130° field of view (Clarity RetCam 3); wide-field fundus photograph of an infant.
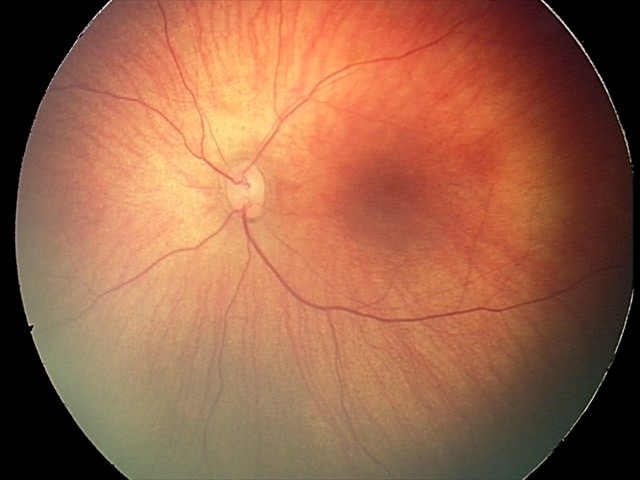
Screening series with retinal hemorrhages.